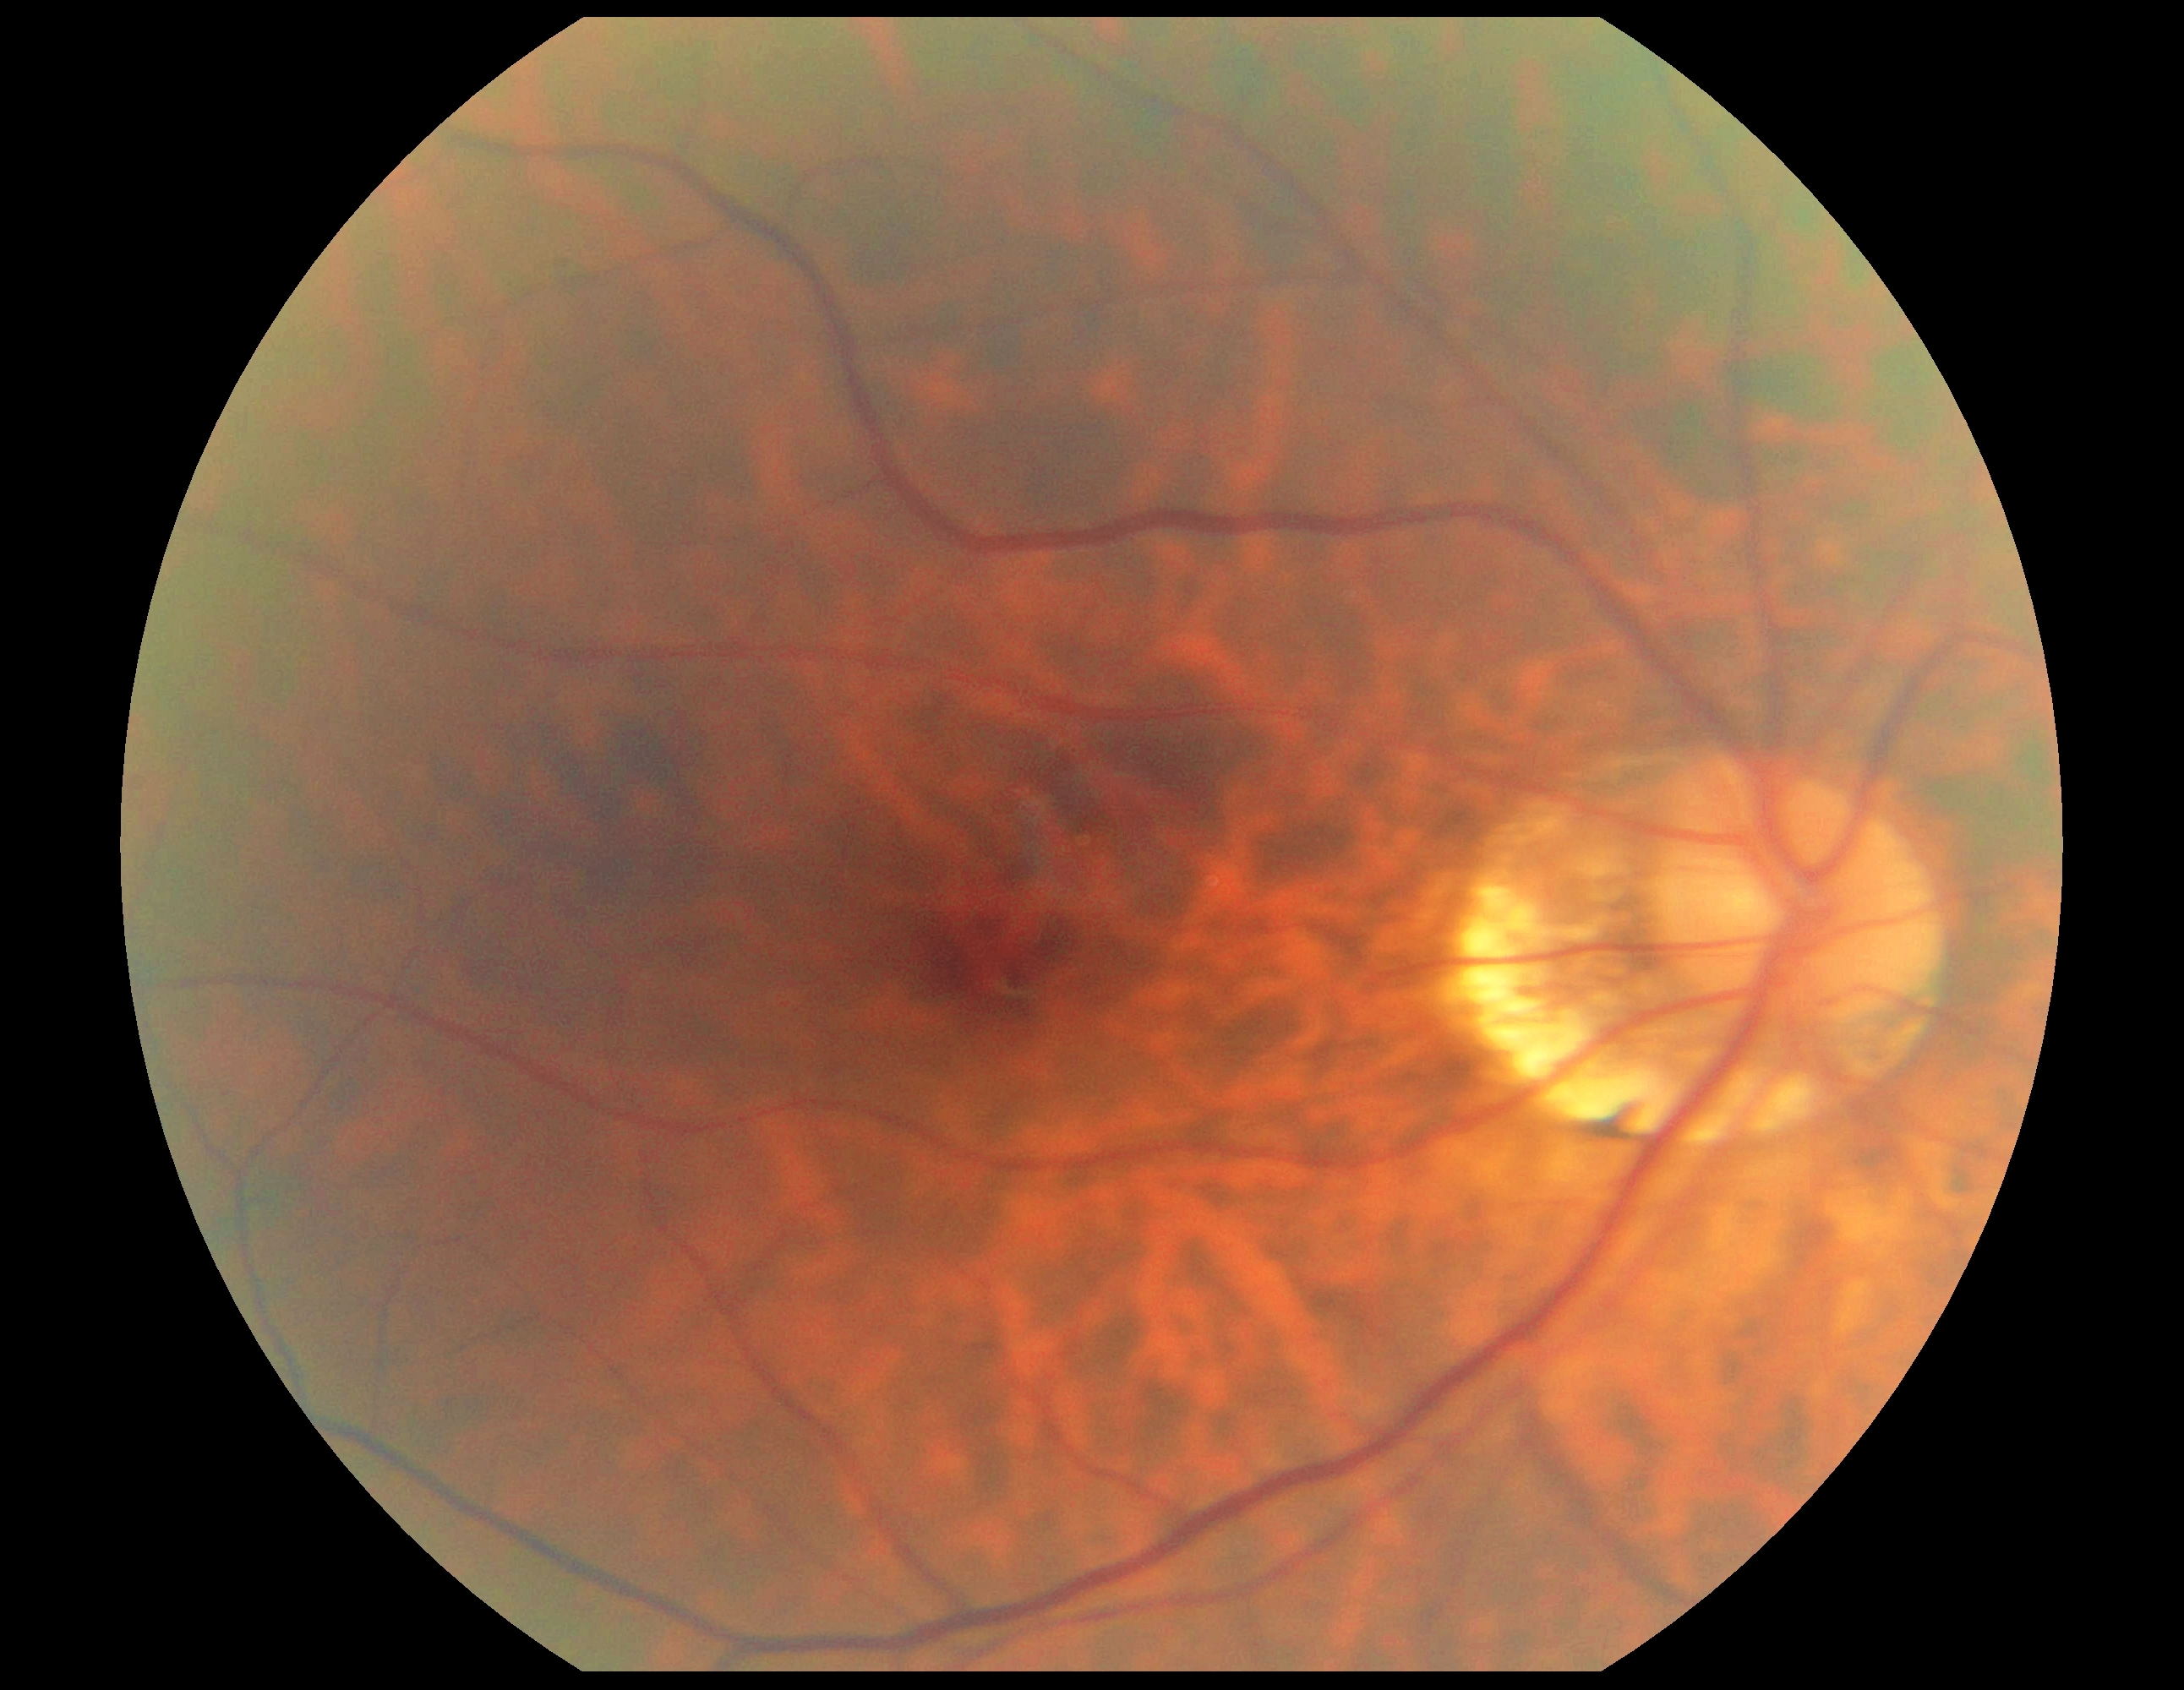

DR severity: grade 0 — no visible signs of diabetic retinopathy.